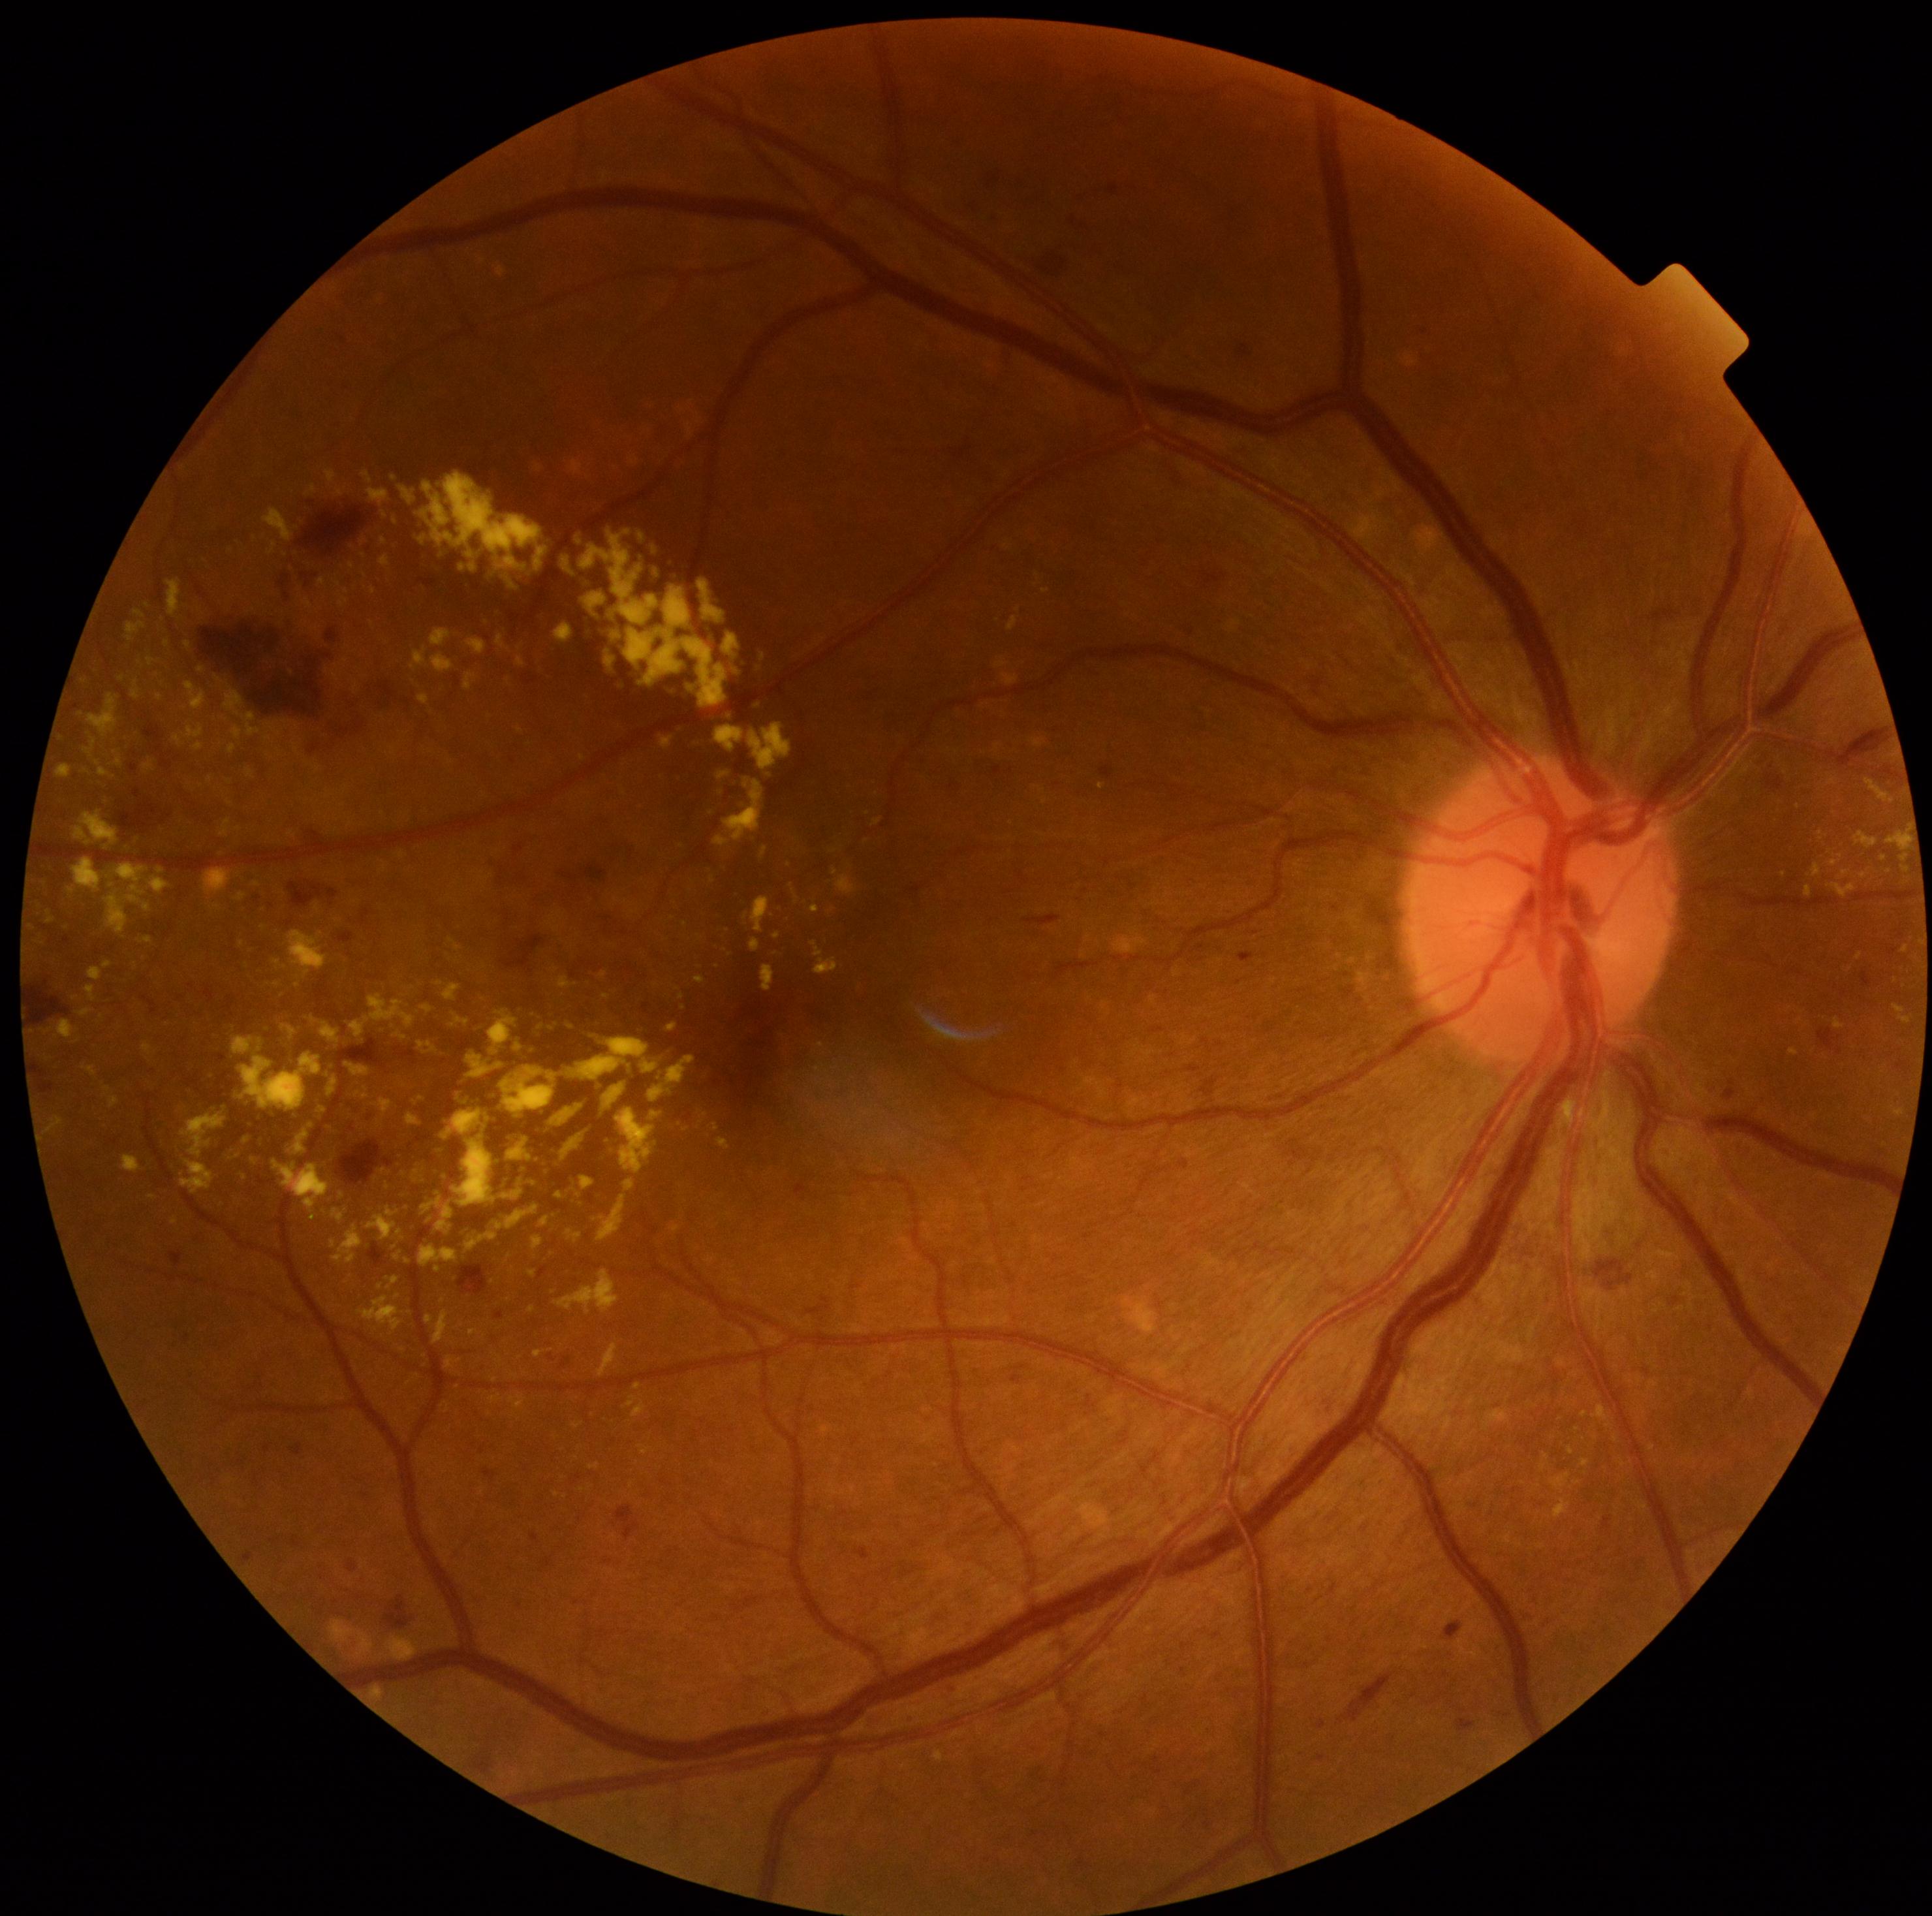 {"partial":true,"dr_grade":2,"dr_grade_name":"moderate NPDR","lesions":{"ex":[[228,743,237,755],[533,1235,544,1251],[87,967,102,981],[621,786,626,795],[343,786,348,794],[42,1020,80,1039],[45,1116,63,1135],[326,790,334,799],[348,563,354,571],[224,689,263,743],[572,462,583,475],[237,893,246,902],[760,965,776,991],[555,1192,563,1200]],"ex_small":[[255,540],[404,1350],[153,1197],[521,731],[834,852]]}}